Natus RetCam Envision, 130° FOV; RetCam wide-field infant fundus image; 1440 by 1080 pixels — 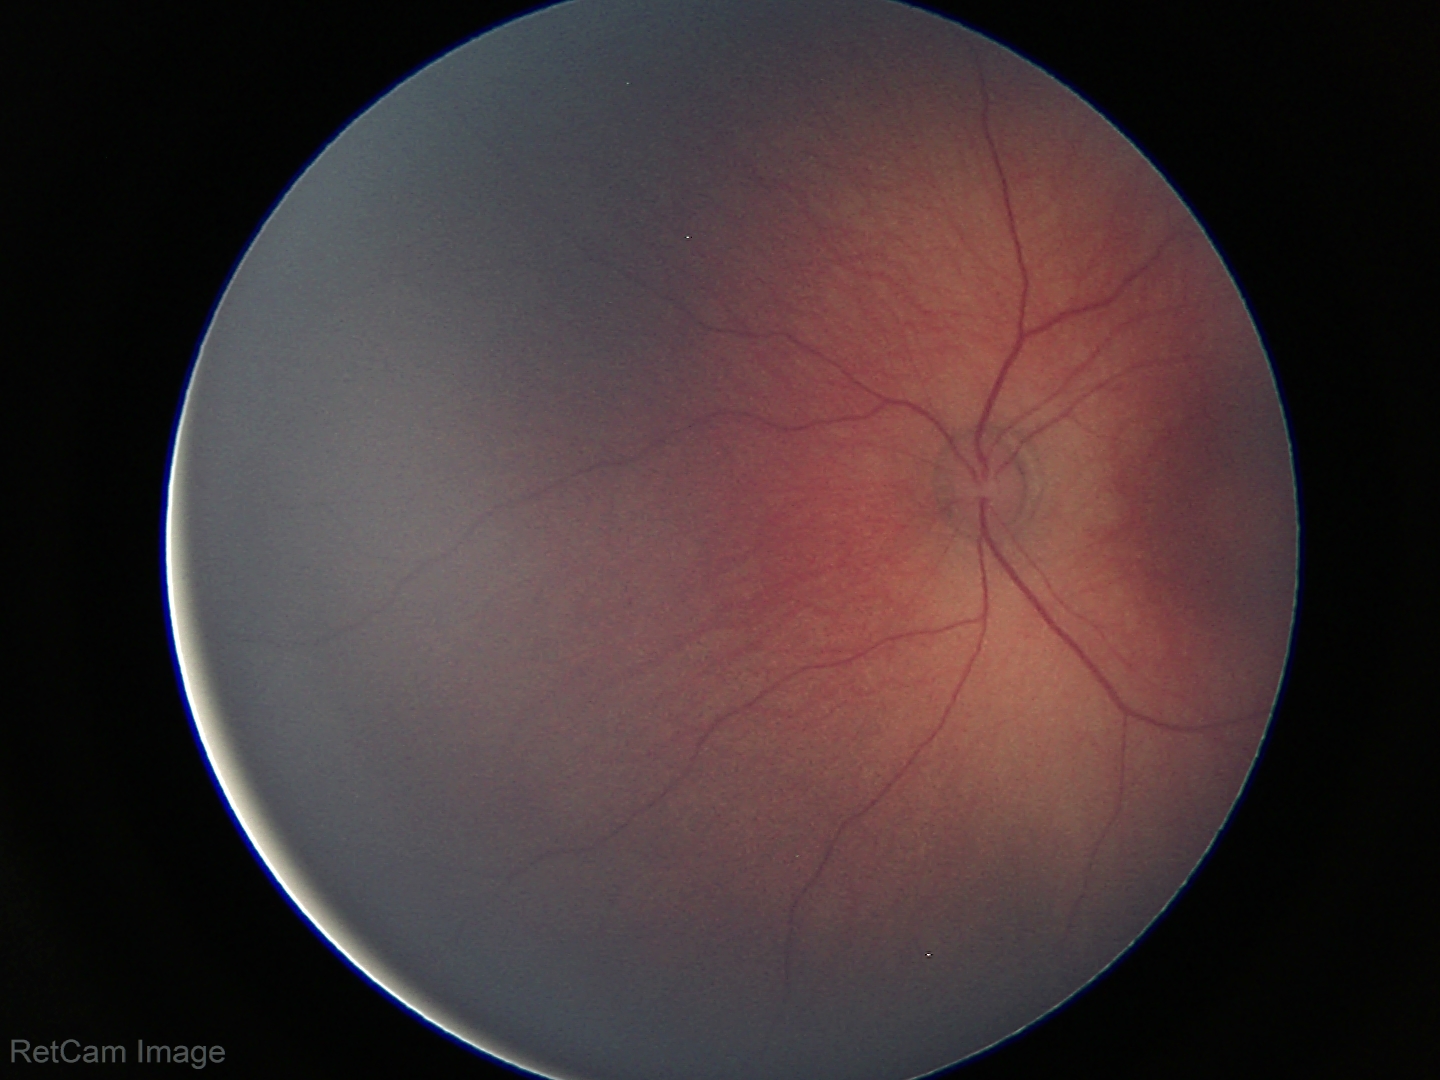

Finding: no abnormalities